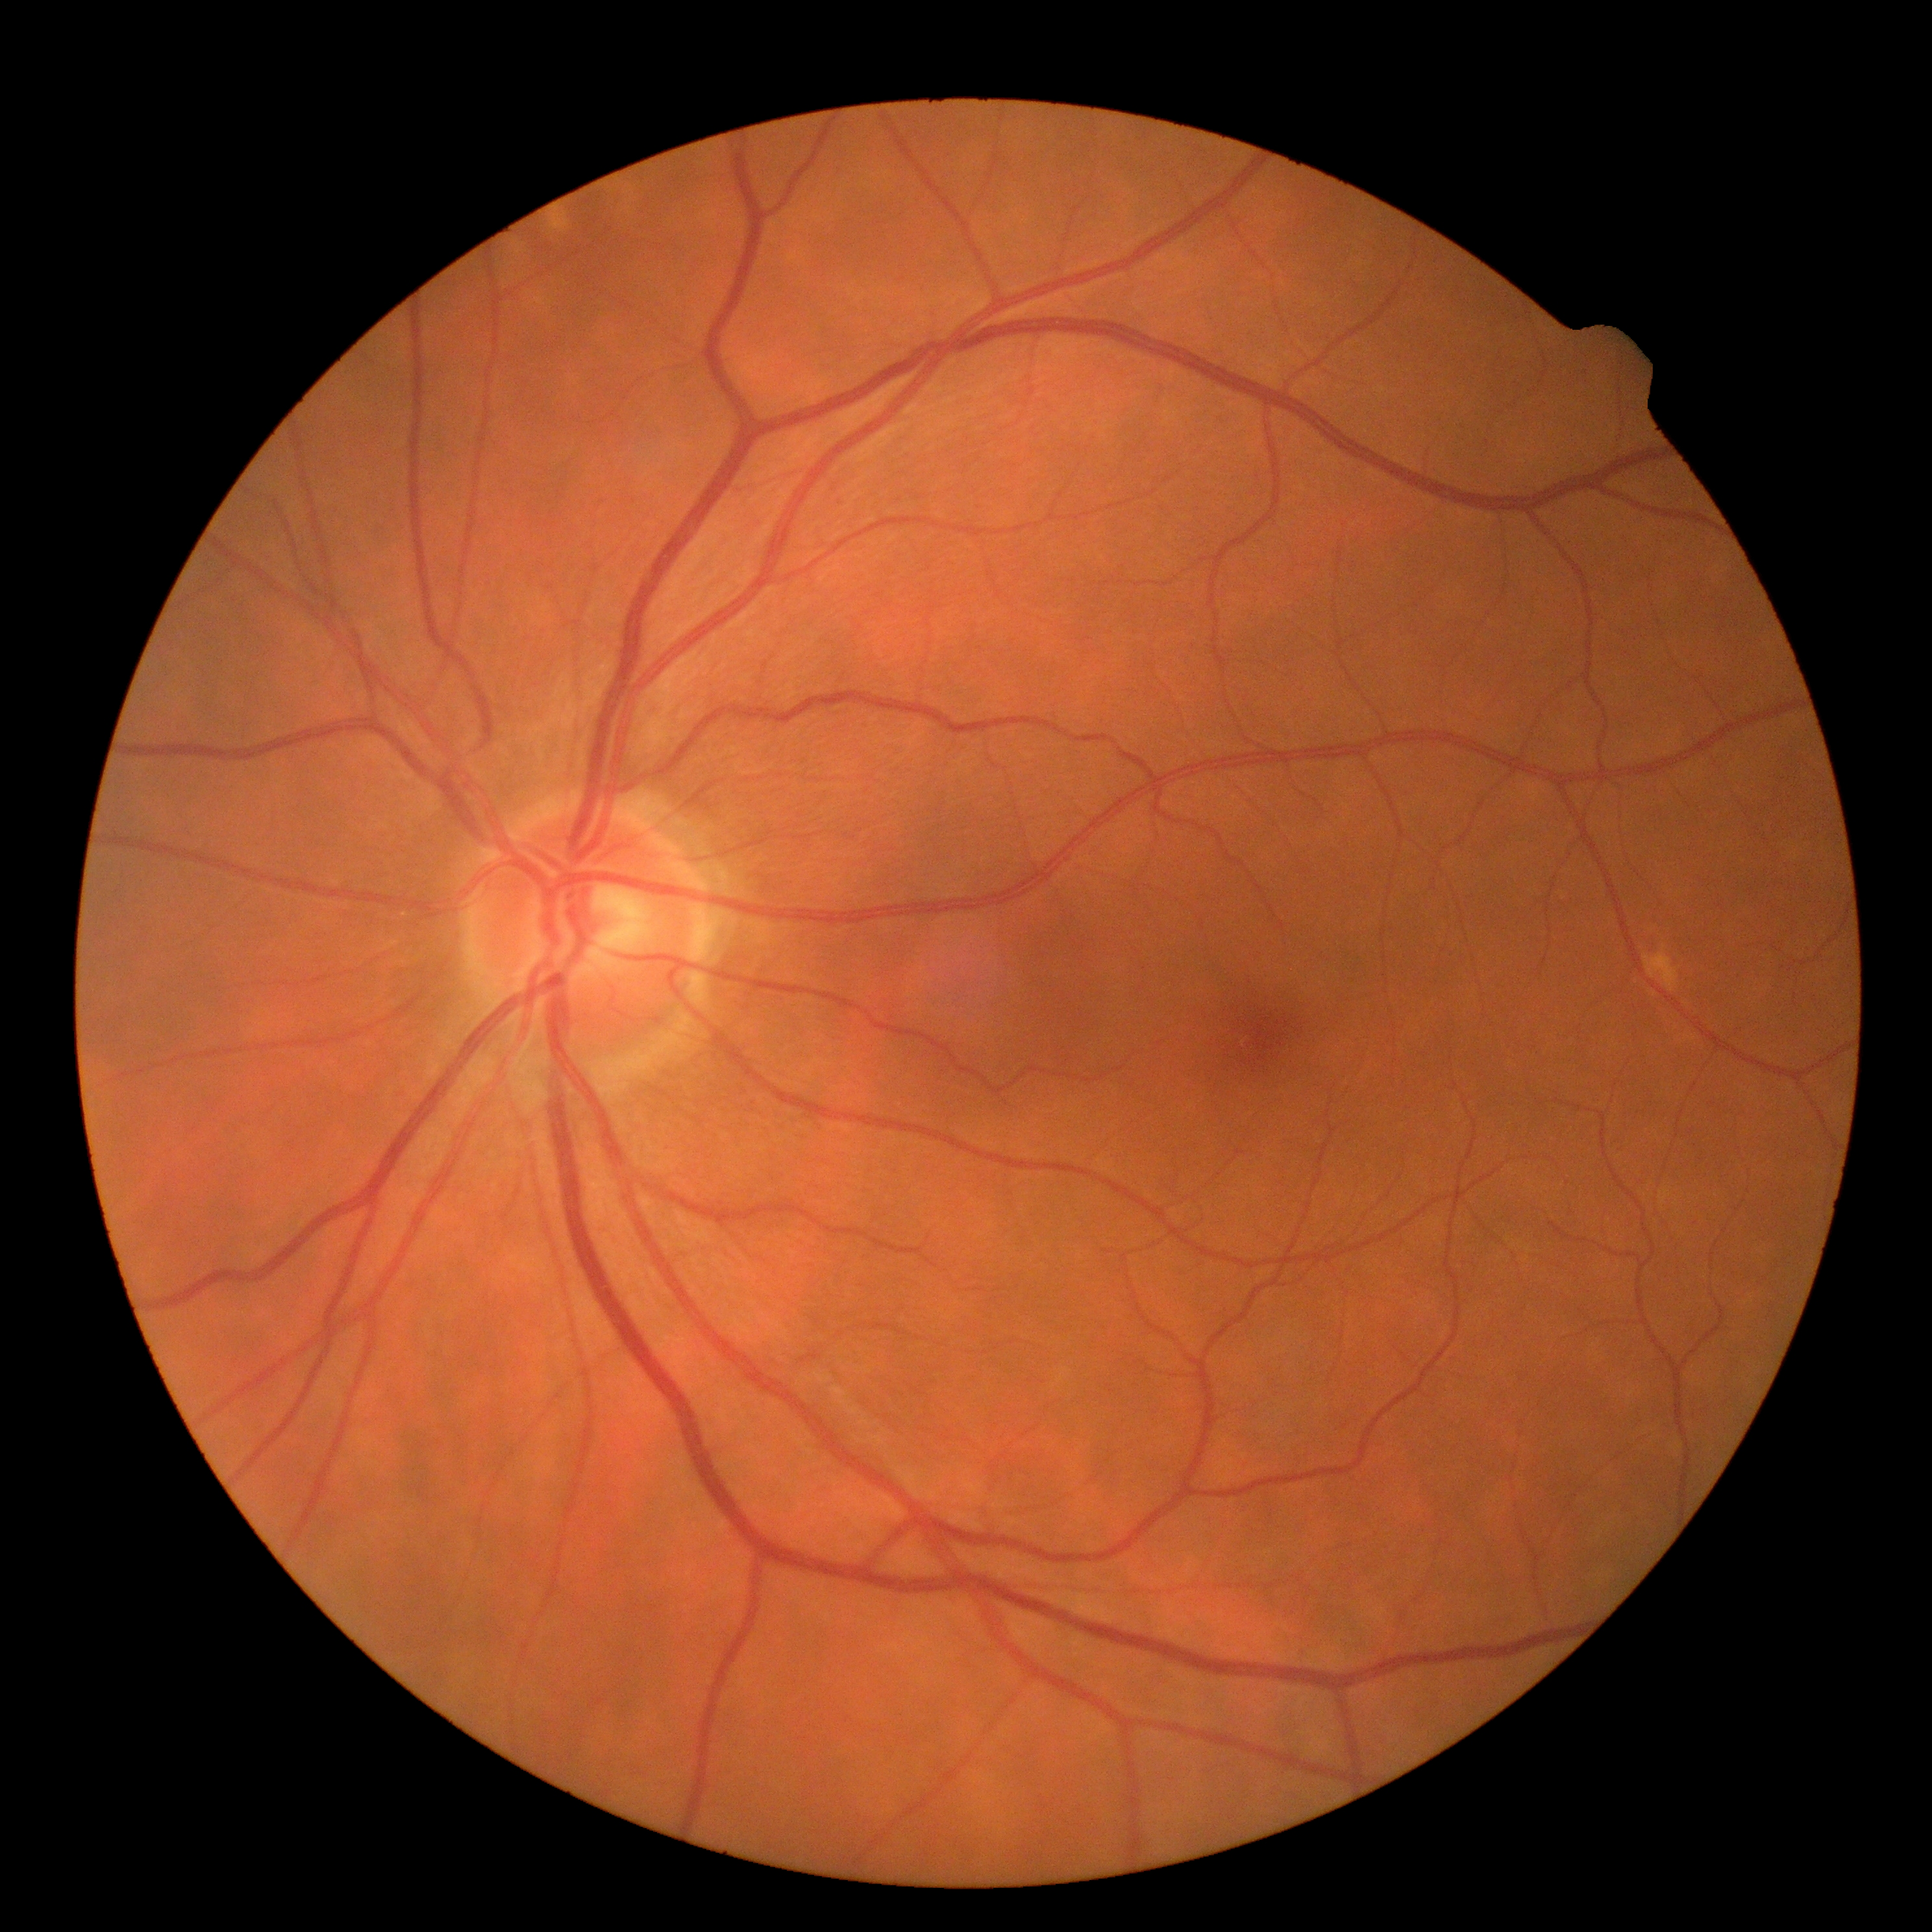

{"dr_grade": "grade 0"}